2352 x 1568 pixels · 45° field of view:
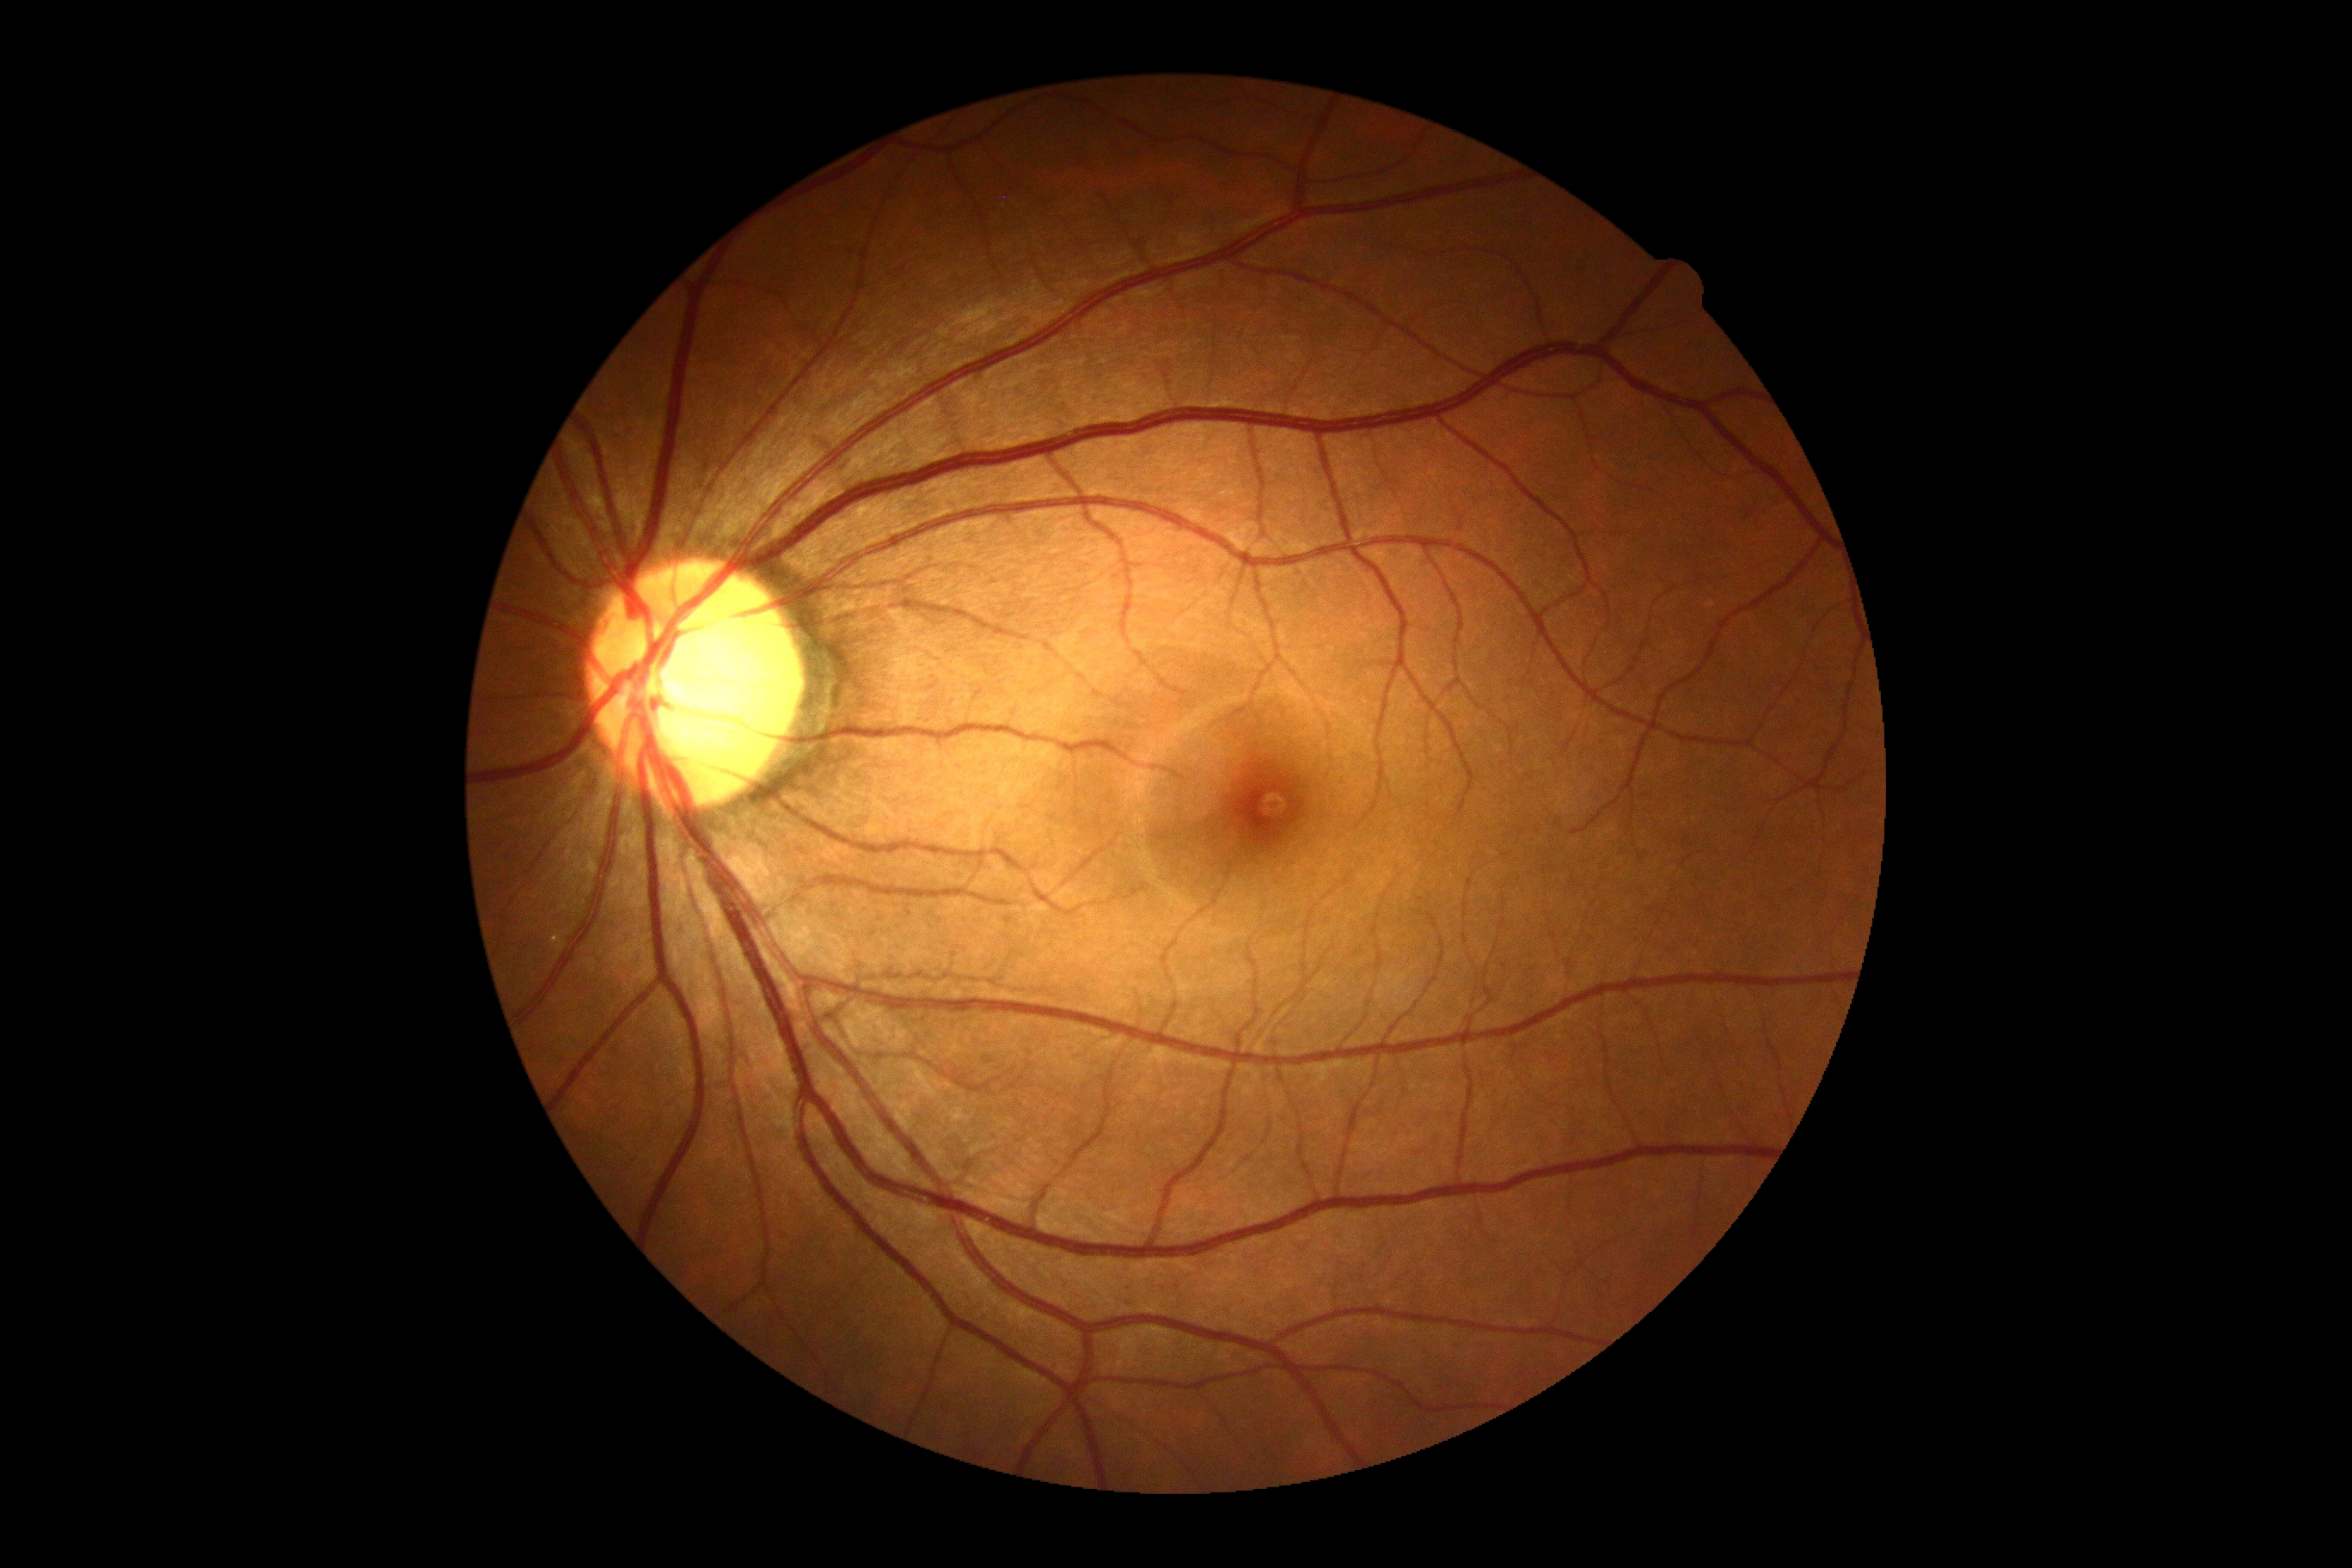 Retinopathy: no apparent retinopathy (grade 0).
No diabetic retinal disease findings.